45° FOV
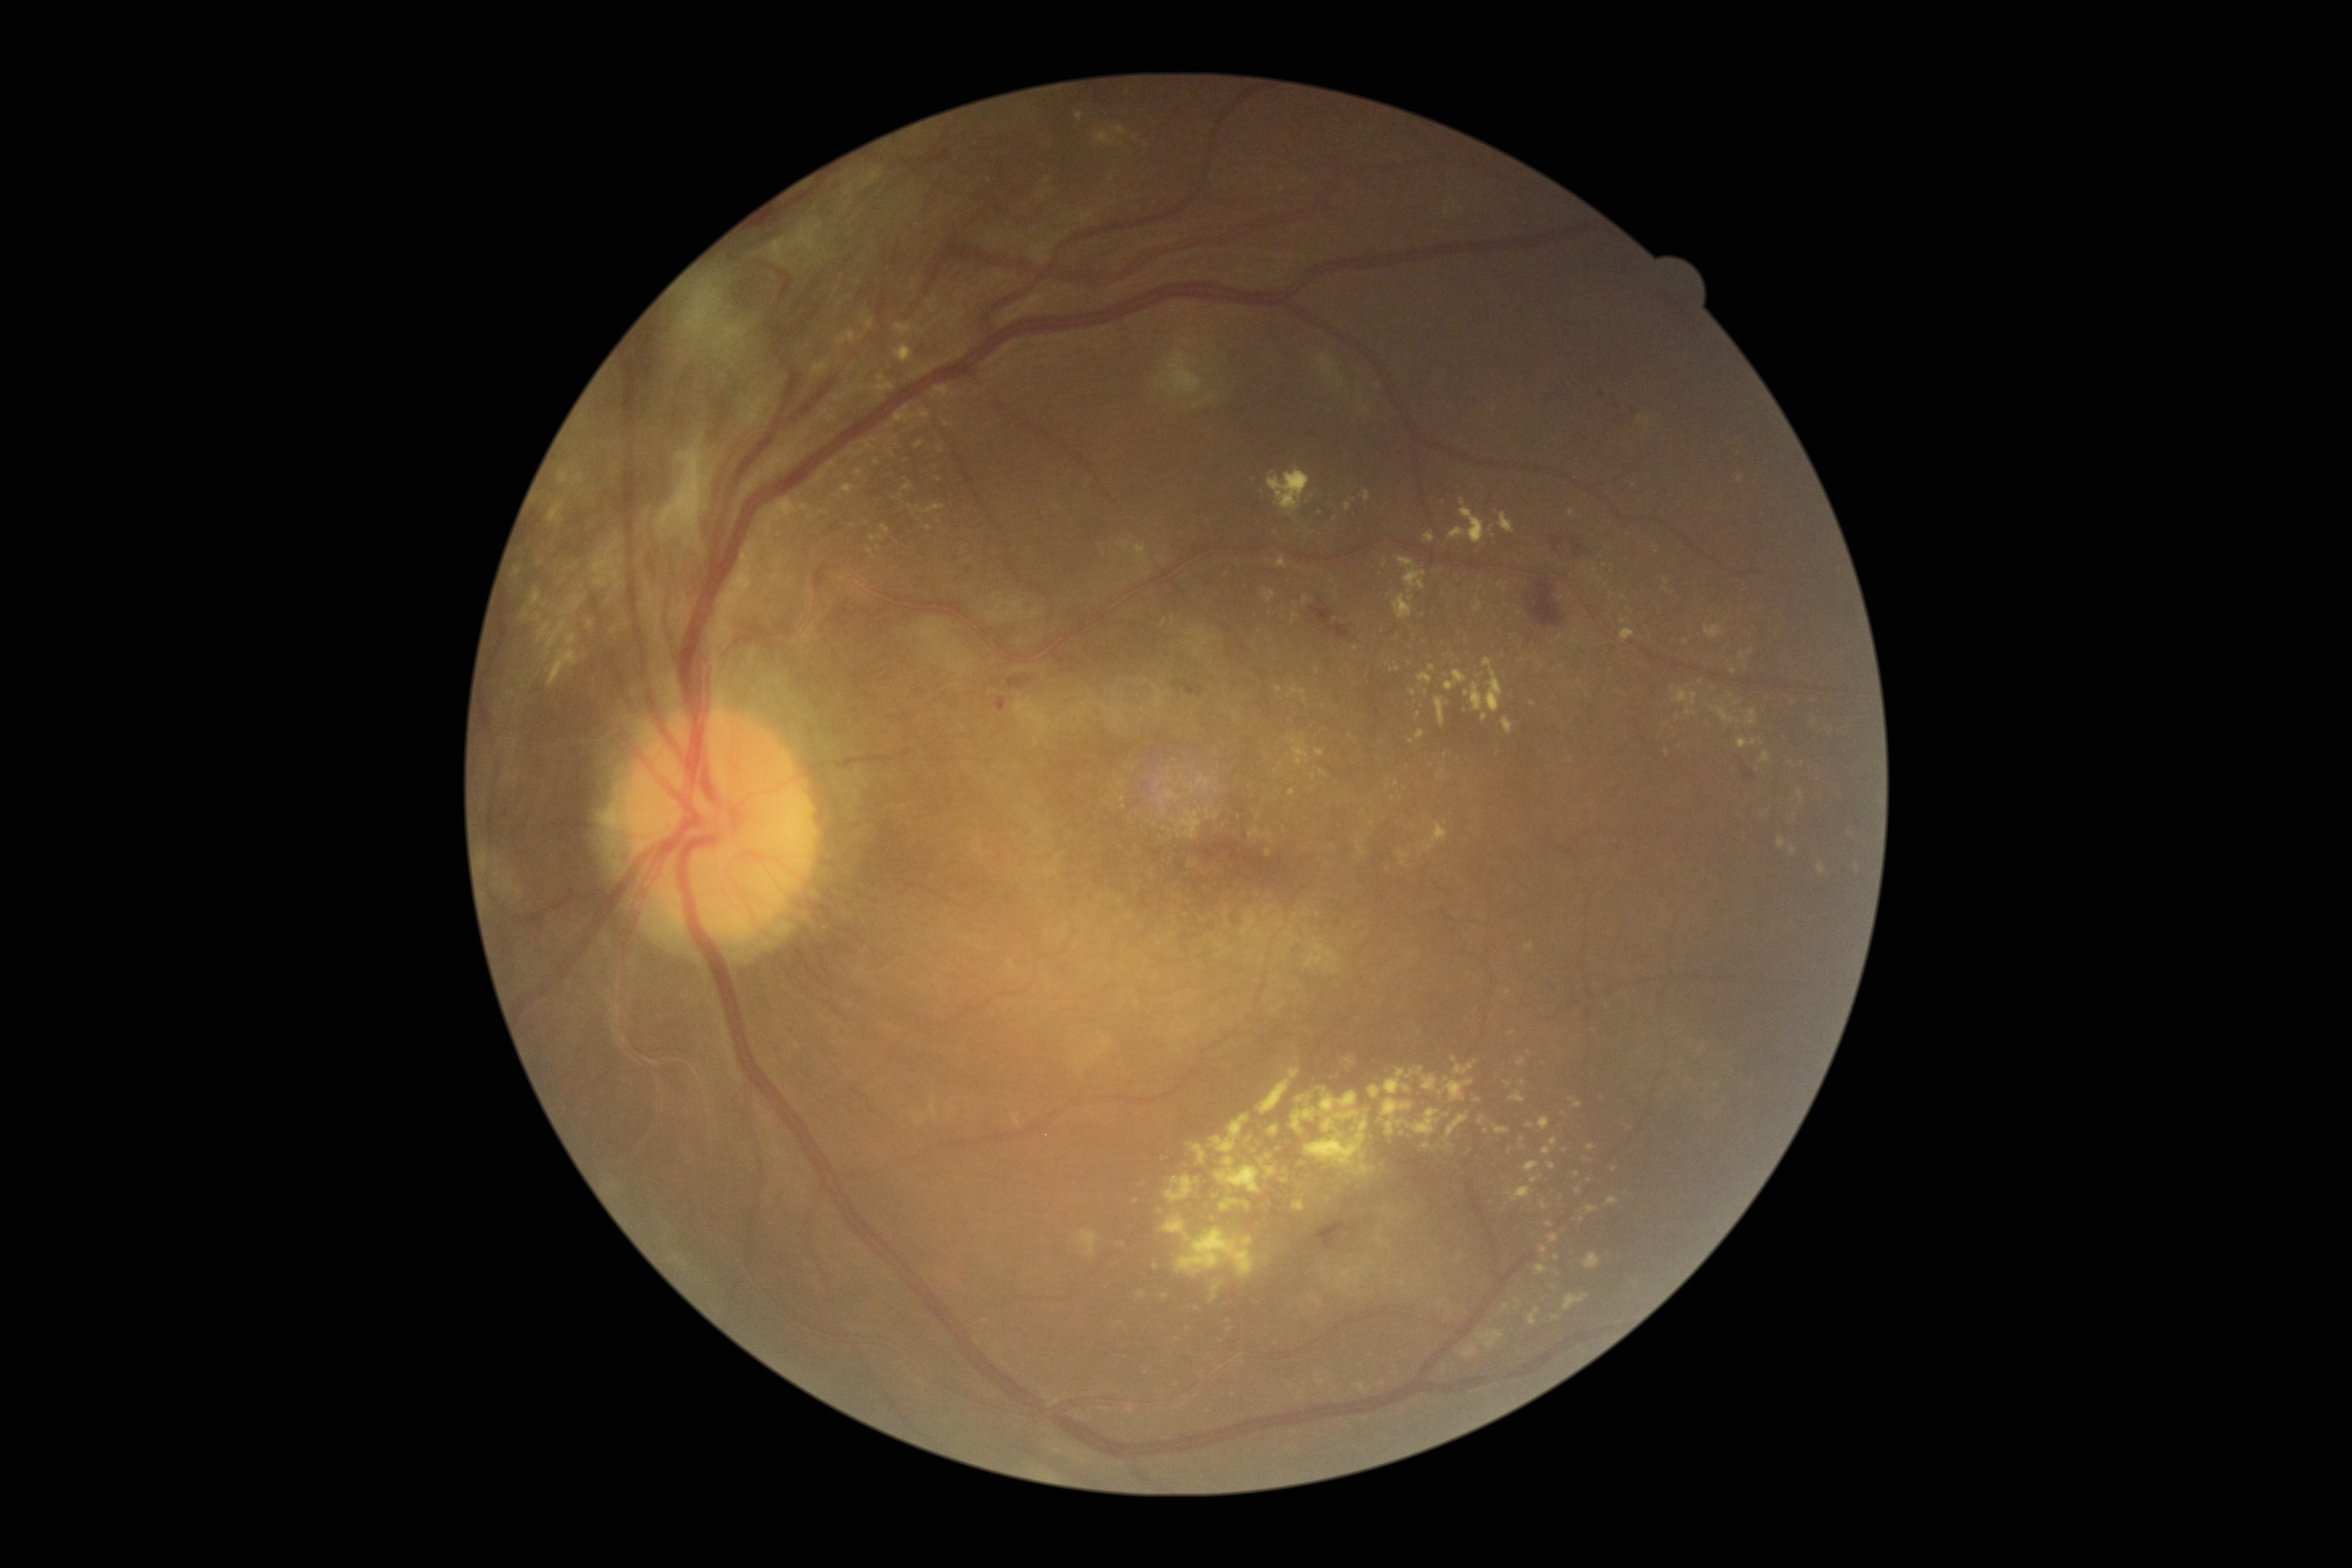 Diabetic retinopathy (DR): proliferative diabetic retinopathy (grade 4)
Selected lesions:
hard exudates (EXs) (continued) = bbox=(546, 630, 580, 687); bbox=(1538, 1116, 1550, 1129); bbox=(915, 441, 924, 449); bbox=(1552, 1315, 1560, 1319); bbox=(1315, 1375, 1327, 1383); bbox=(586, 620, 593, 629); bbox=(1293, 1195, 1306, 1212); bbox=(1445, 670, 1467, 691); bbox=(1439, 1079, 1474, 1102); bbox=(1210, 1281, 1225, 1302); bbox=(1481, 713, 1488, 722); bbox=(1265, 1166, 1276, 1177)
Additional small EXs near {"x": 1328, "y": 1199}; {"x": 860, "y": 388}; {"x": 1453, "y": 1059}; {"x": 1146, "y": 146}; {"x": 1751, "y": 652}; {"x": 1230, "y": 1329}; {"x": 1493, "y": 536}